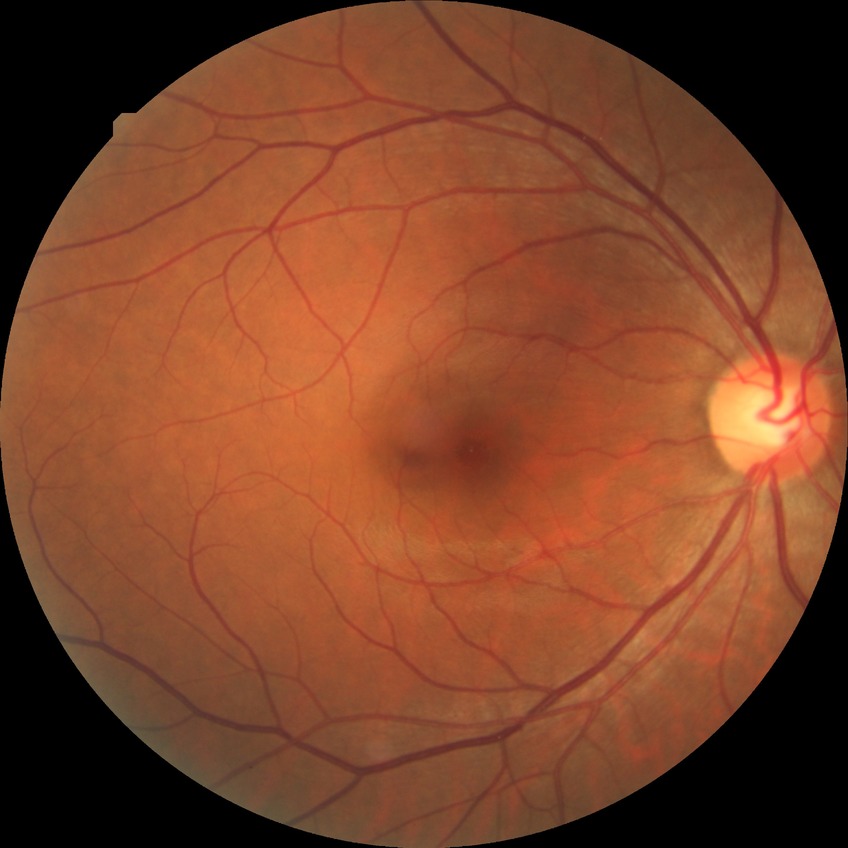

retinopathy grade = no diabetic retinopathy.